2212x1659px: 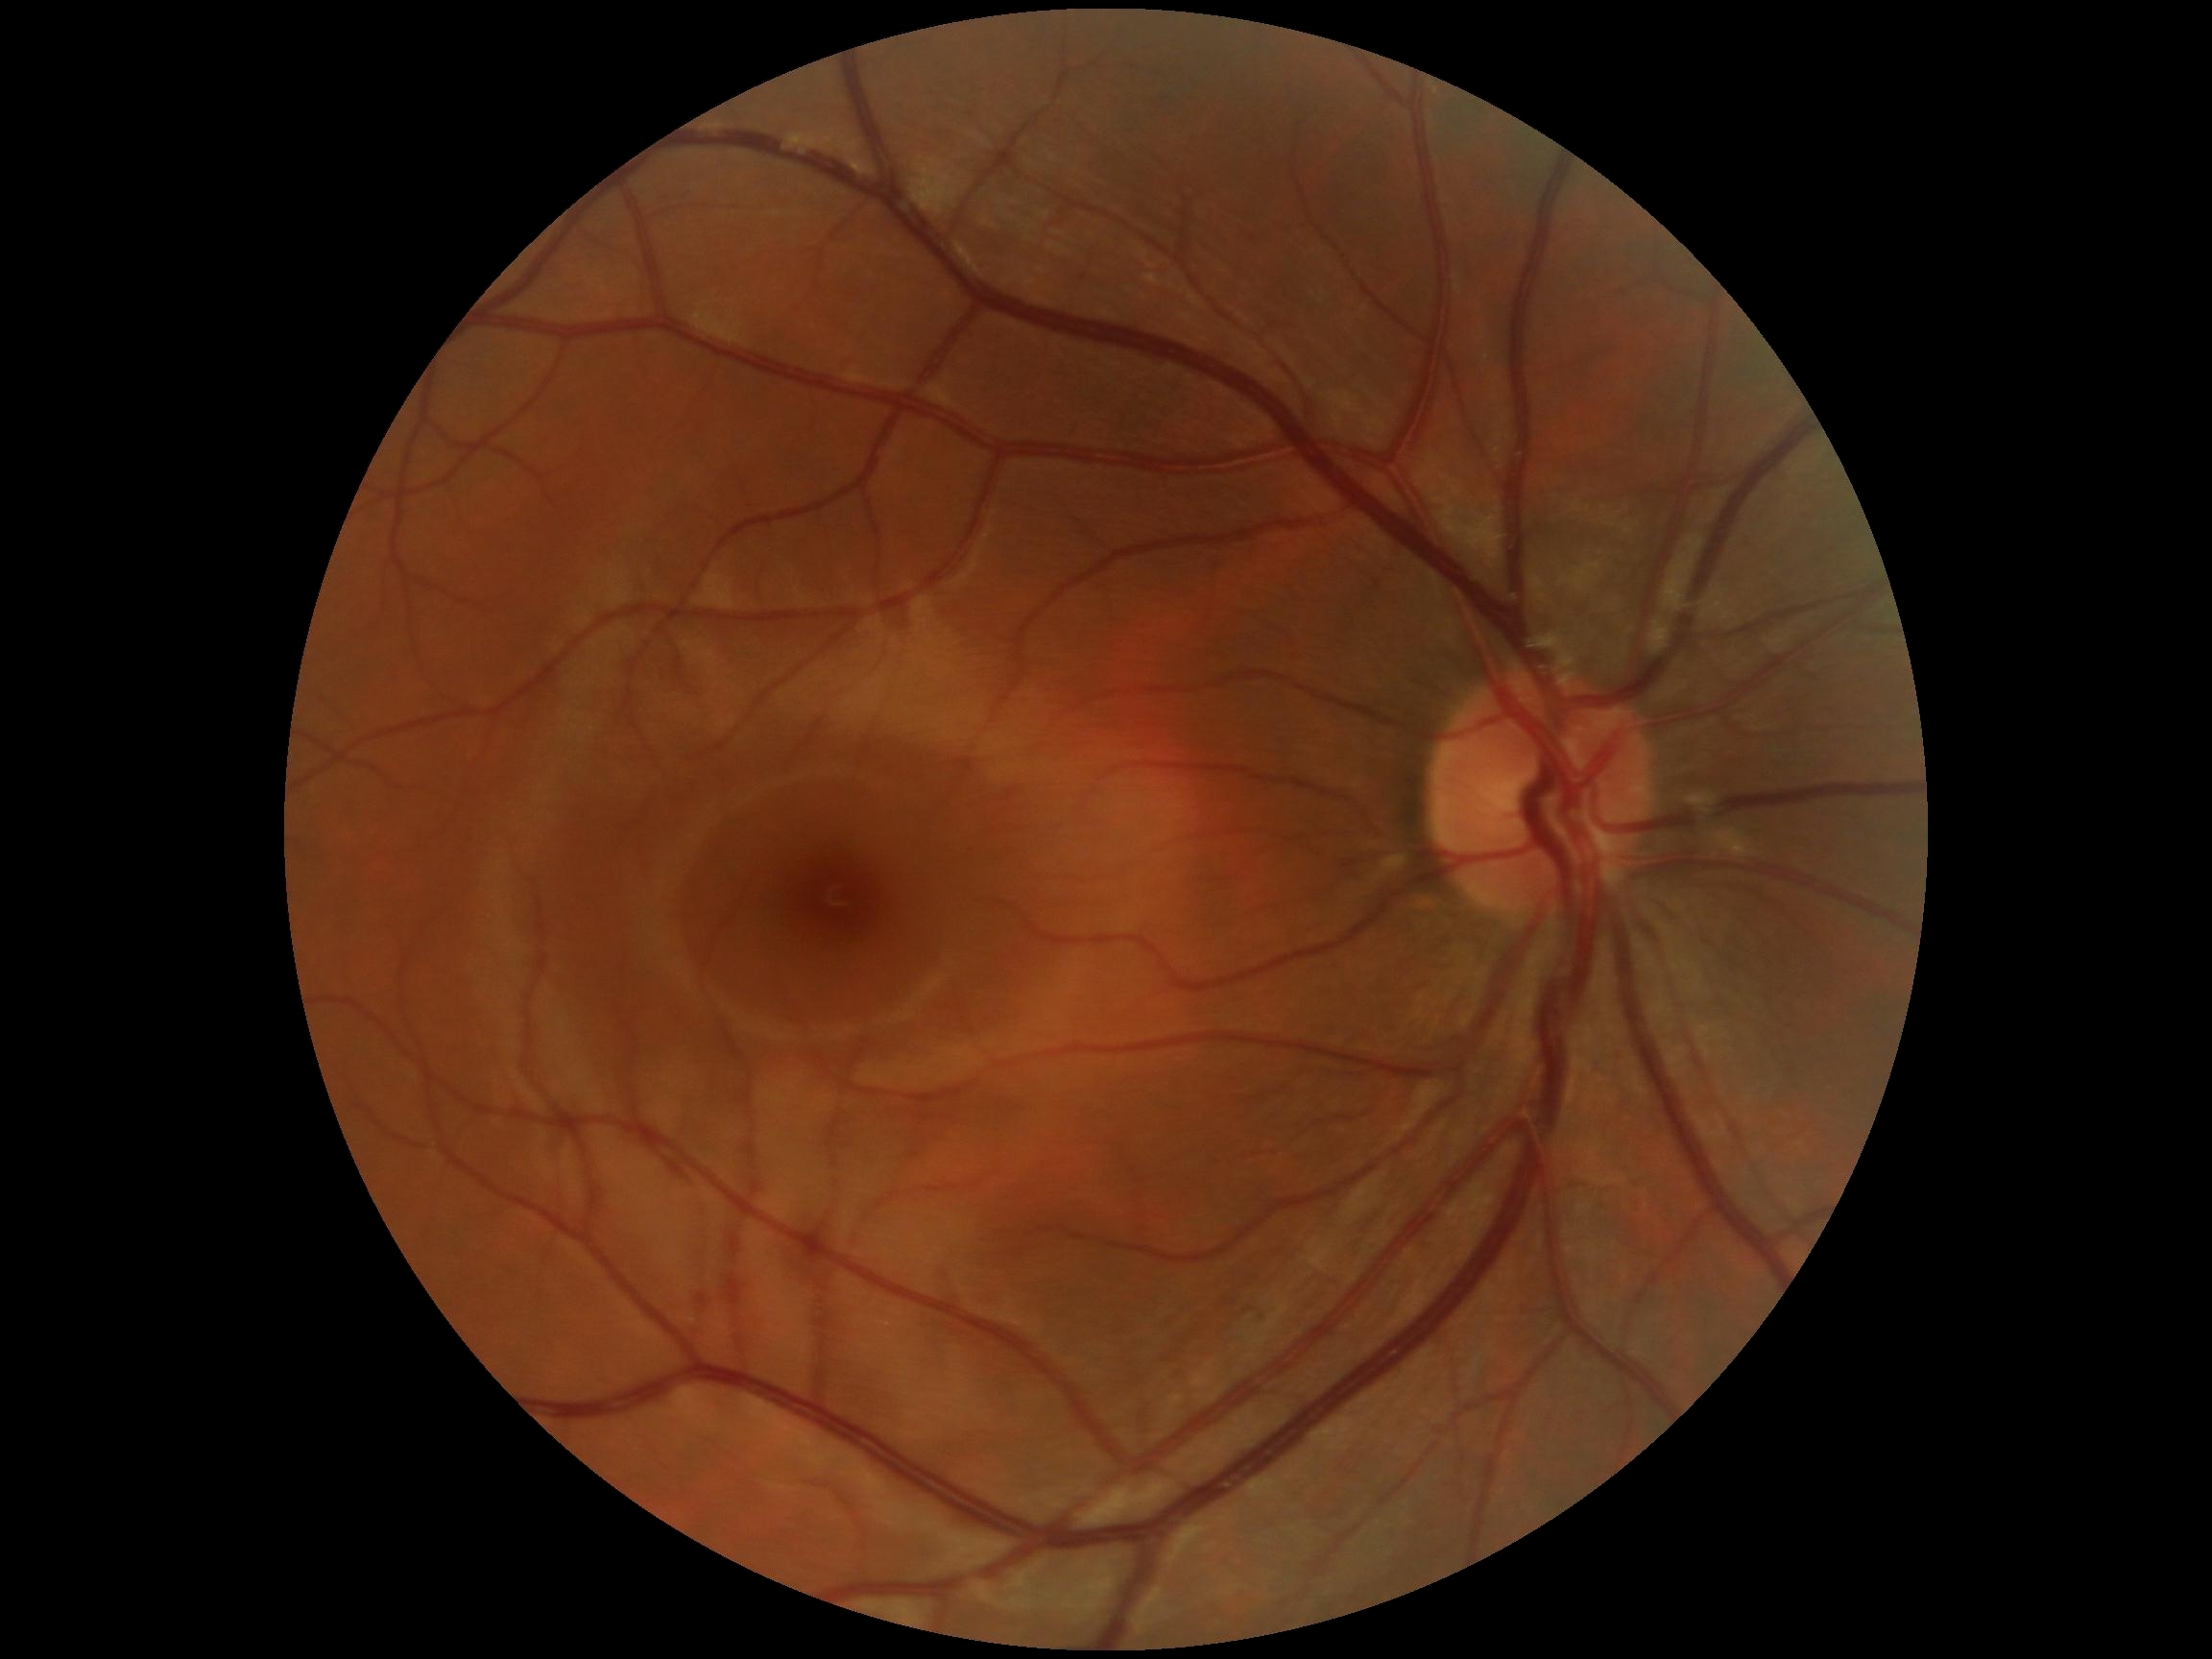 DR impression: no DR findings; DR grade: 0 (no apparent retinopathy) — no visible signs of diabetic retinopathy.